Wide-field fundus photograph of an infant:
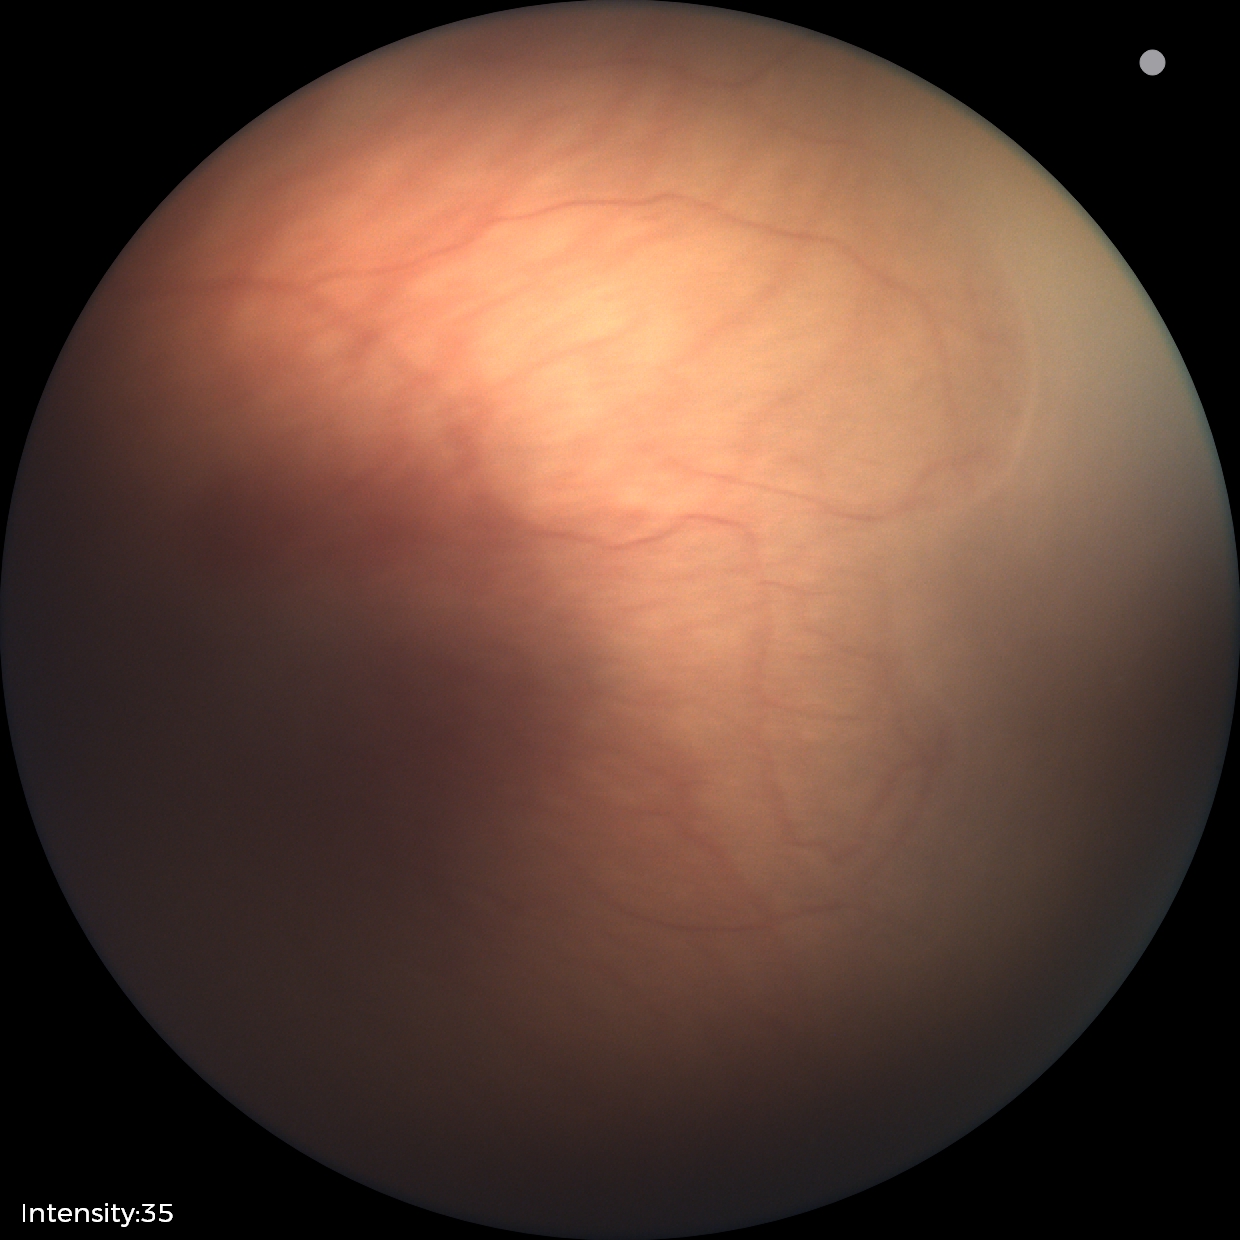 ROP stage = 1 | plus form = absent.